Modified Davis grading: 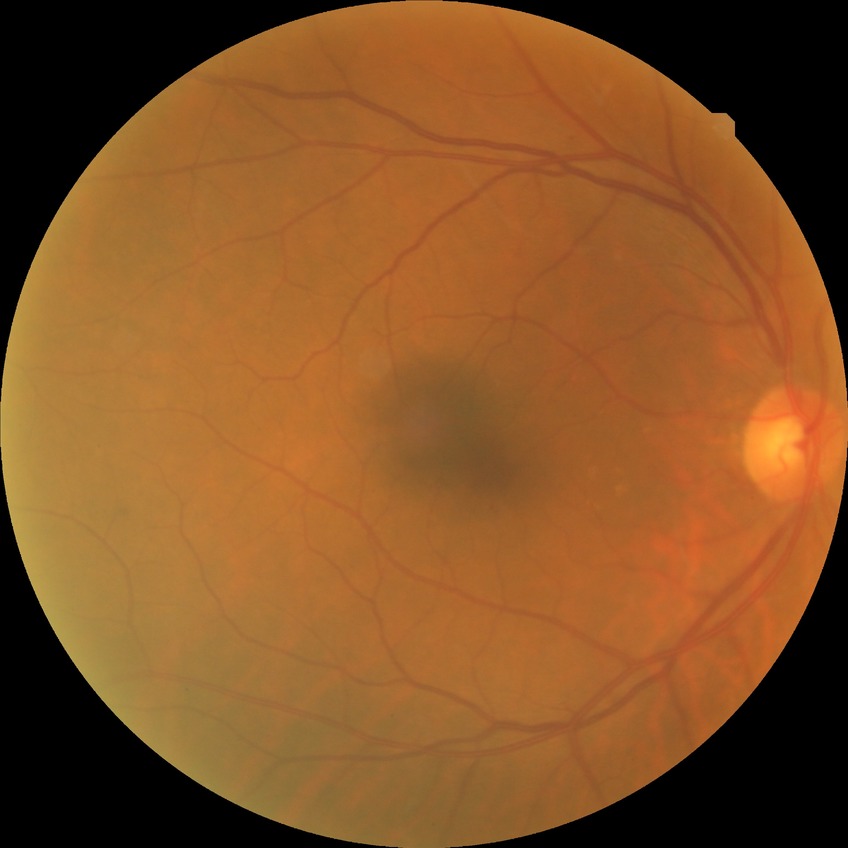 Davis grade: NDR. No DR findings.